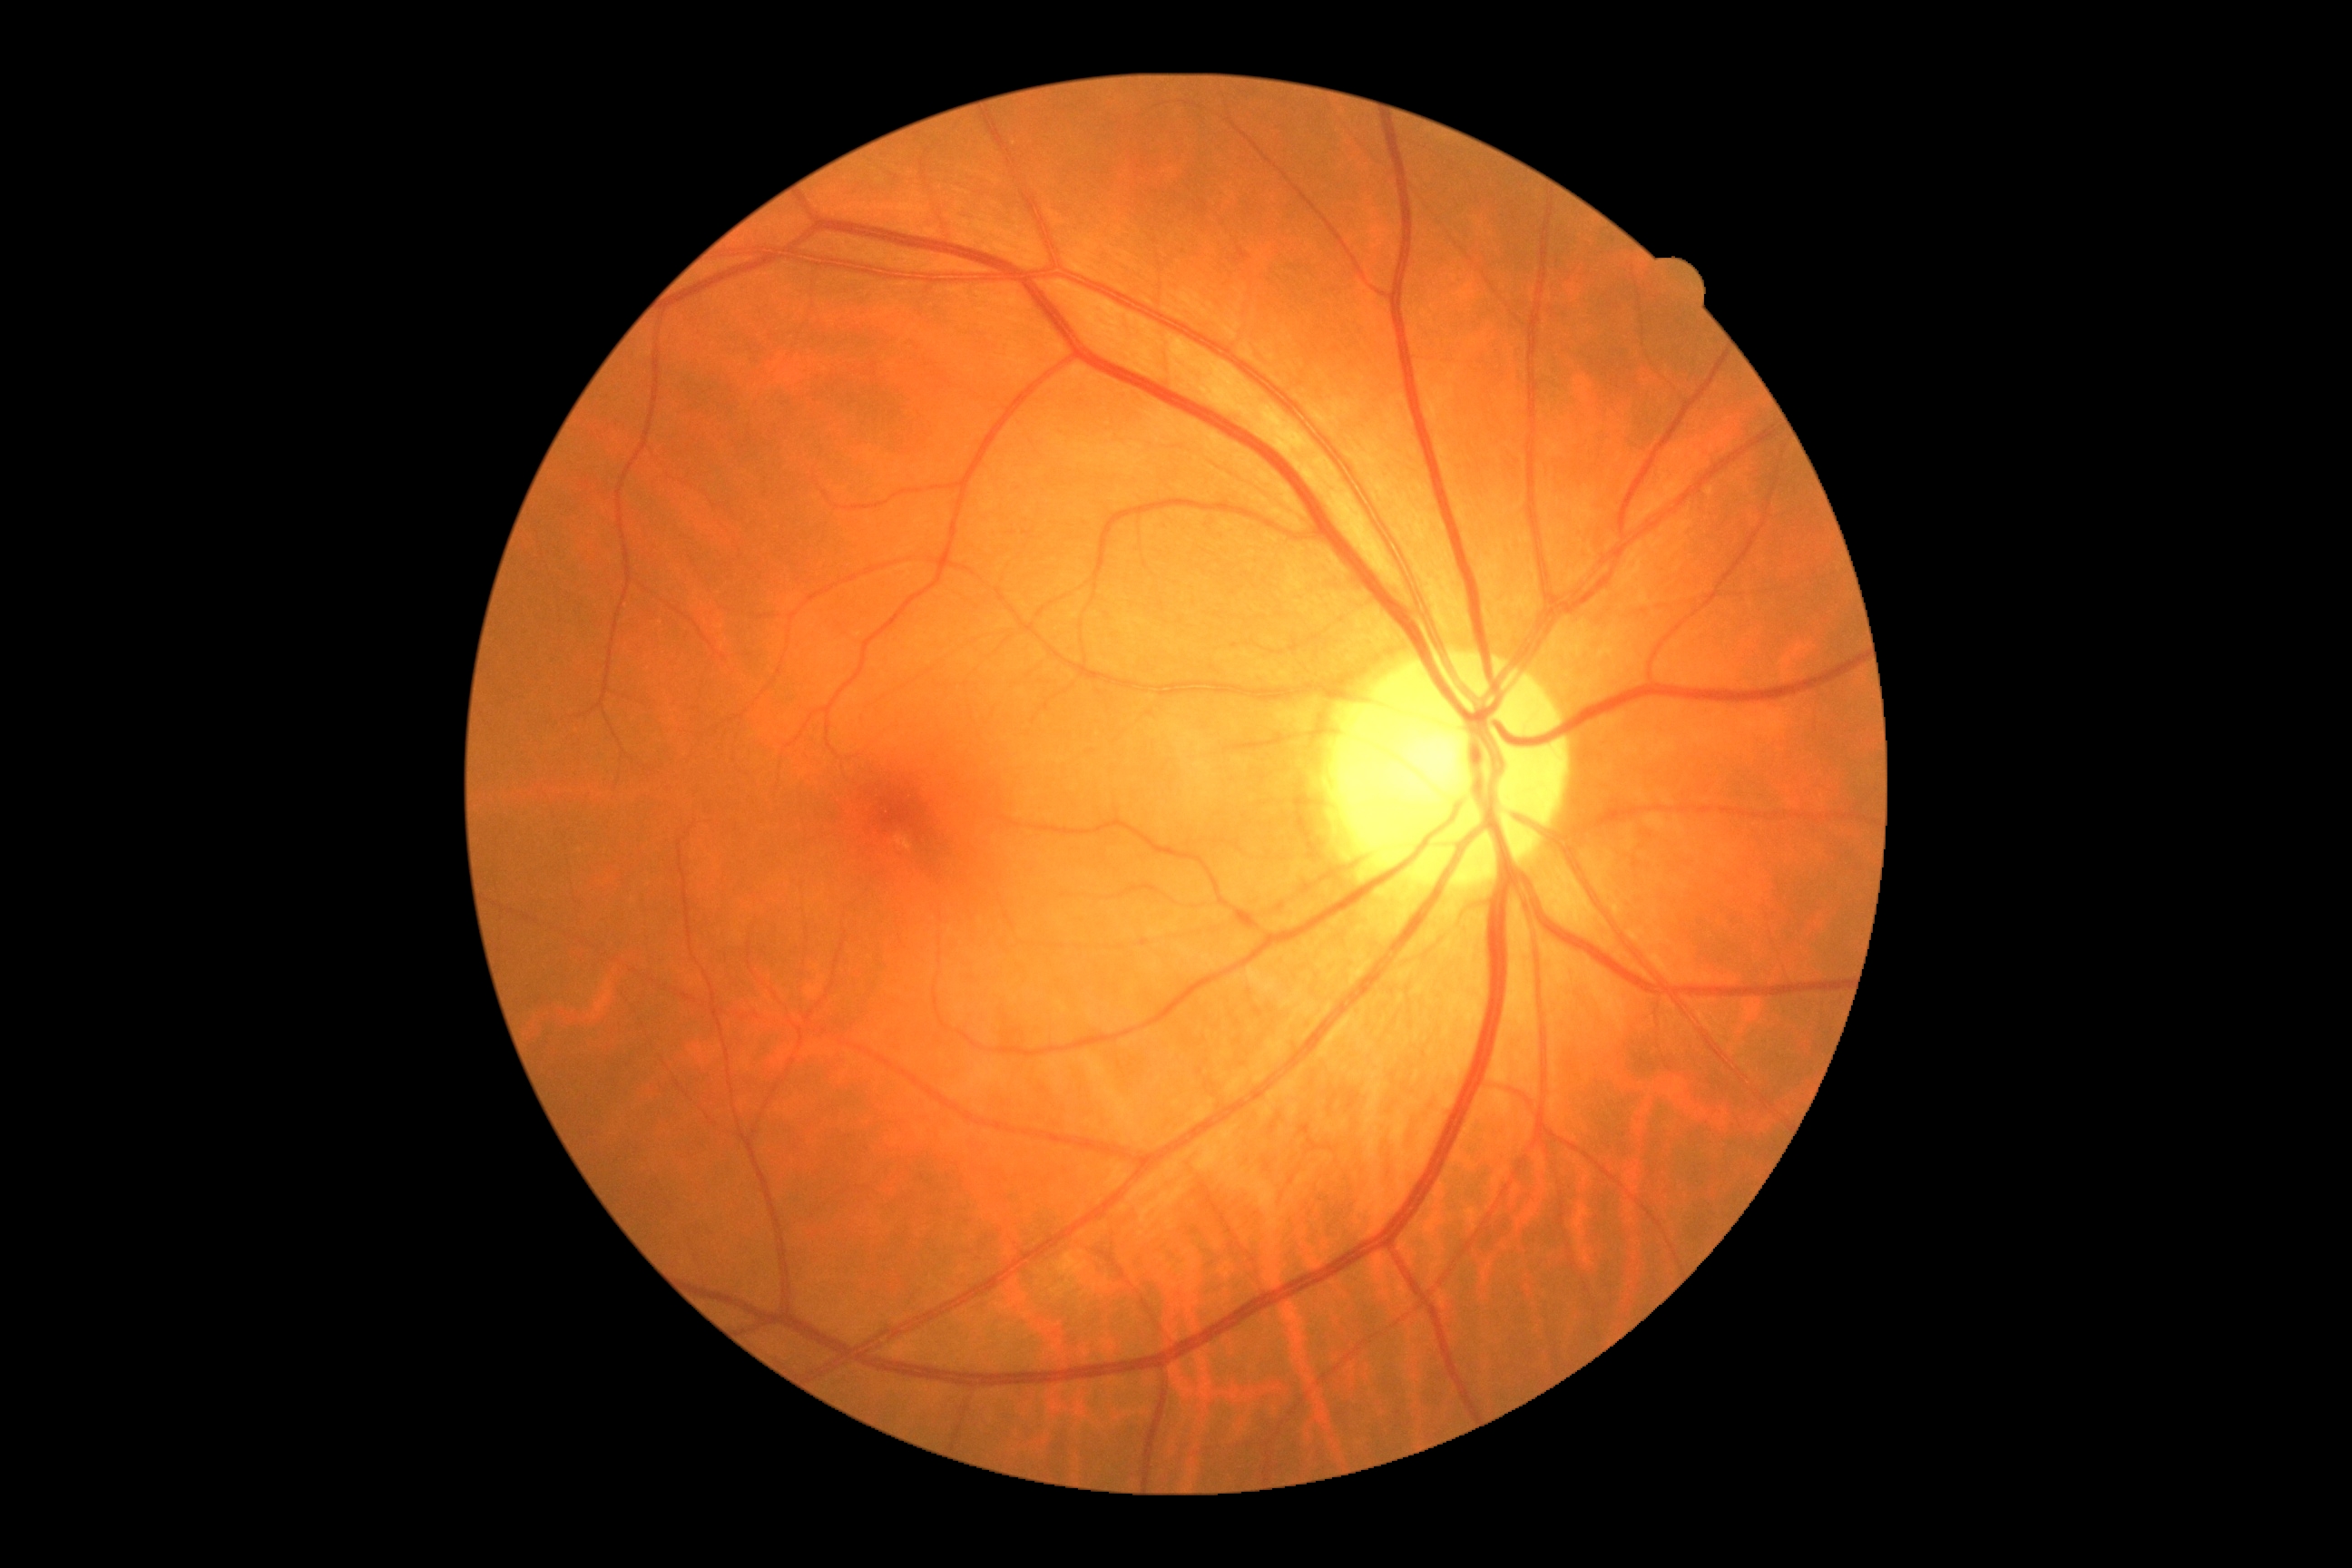 DR grade is no apparent diabetic retinopathy (0) — no visible signs of diabetic retinopathy.